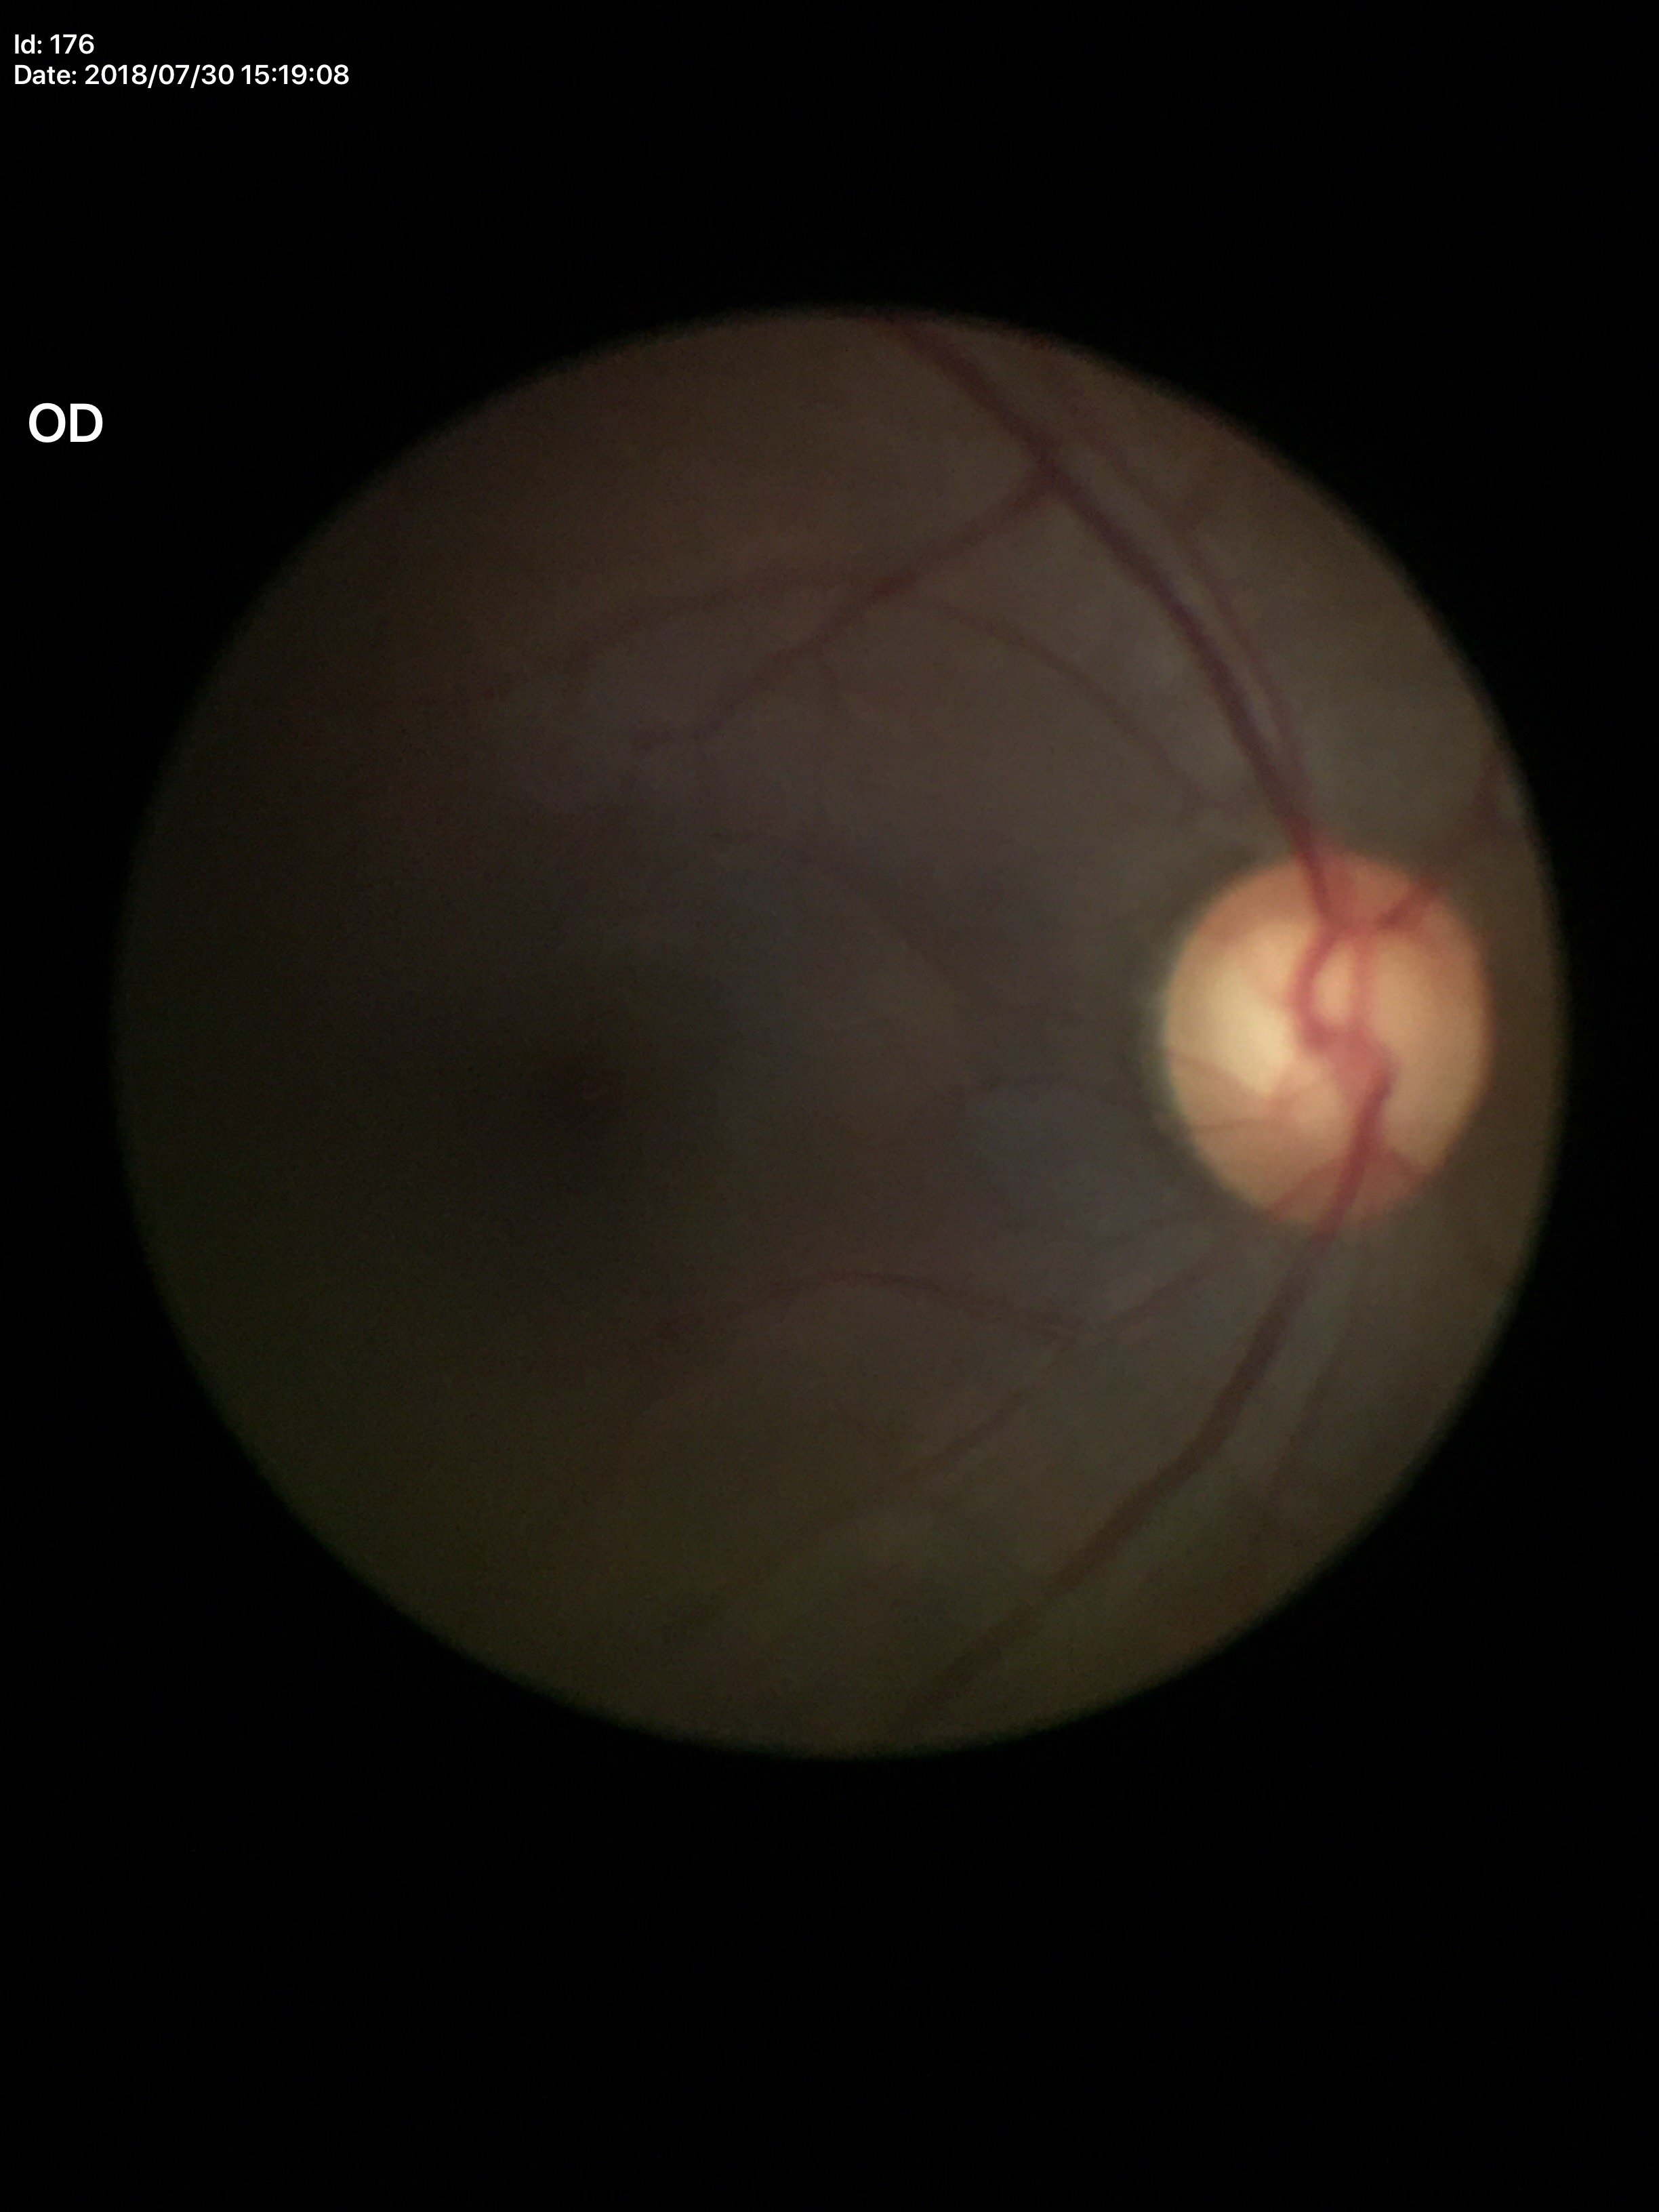

Concerning for glaucoma. VCDR of 0.61. HCDR of 0.69.